50° field of view · color fundus photograph — 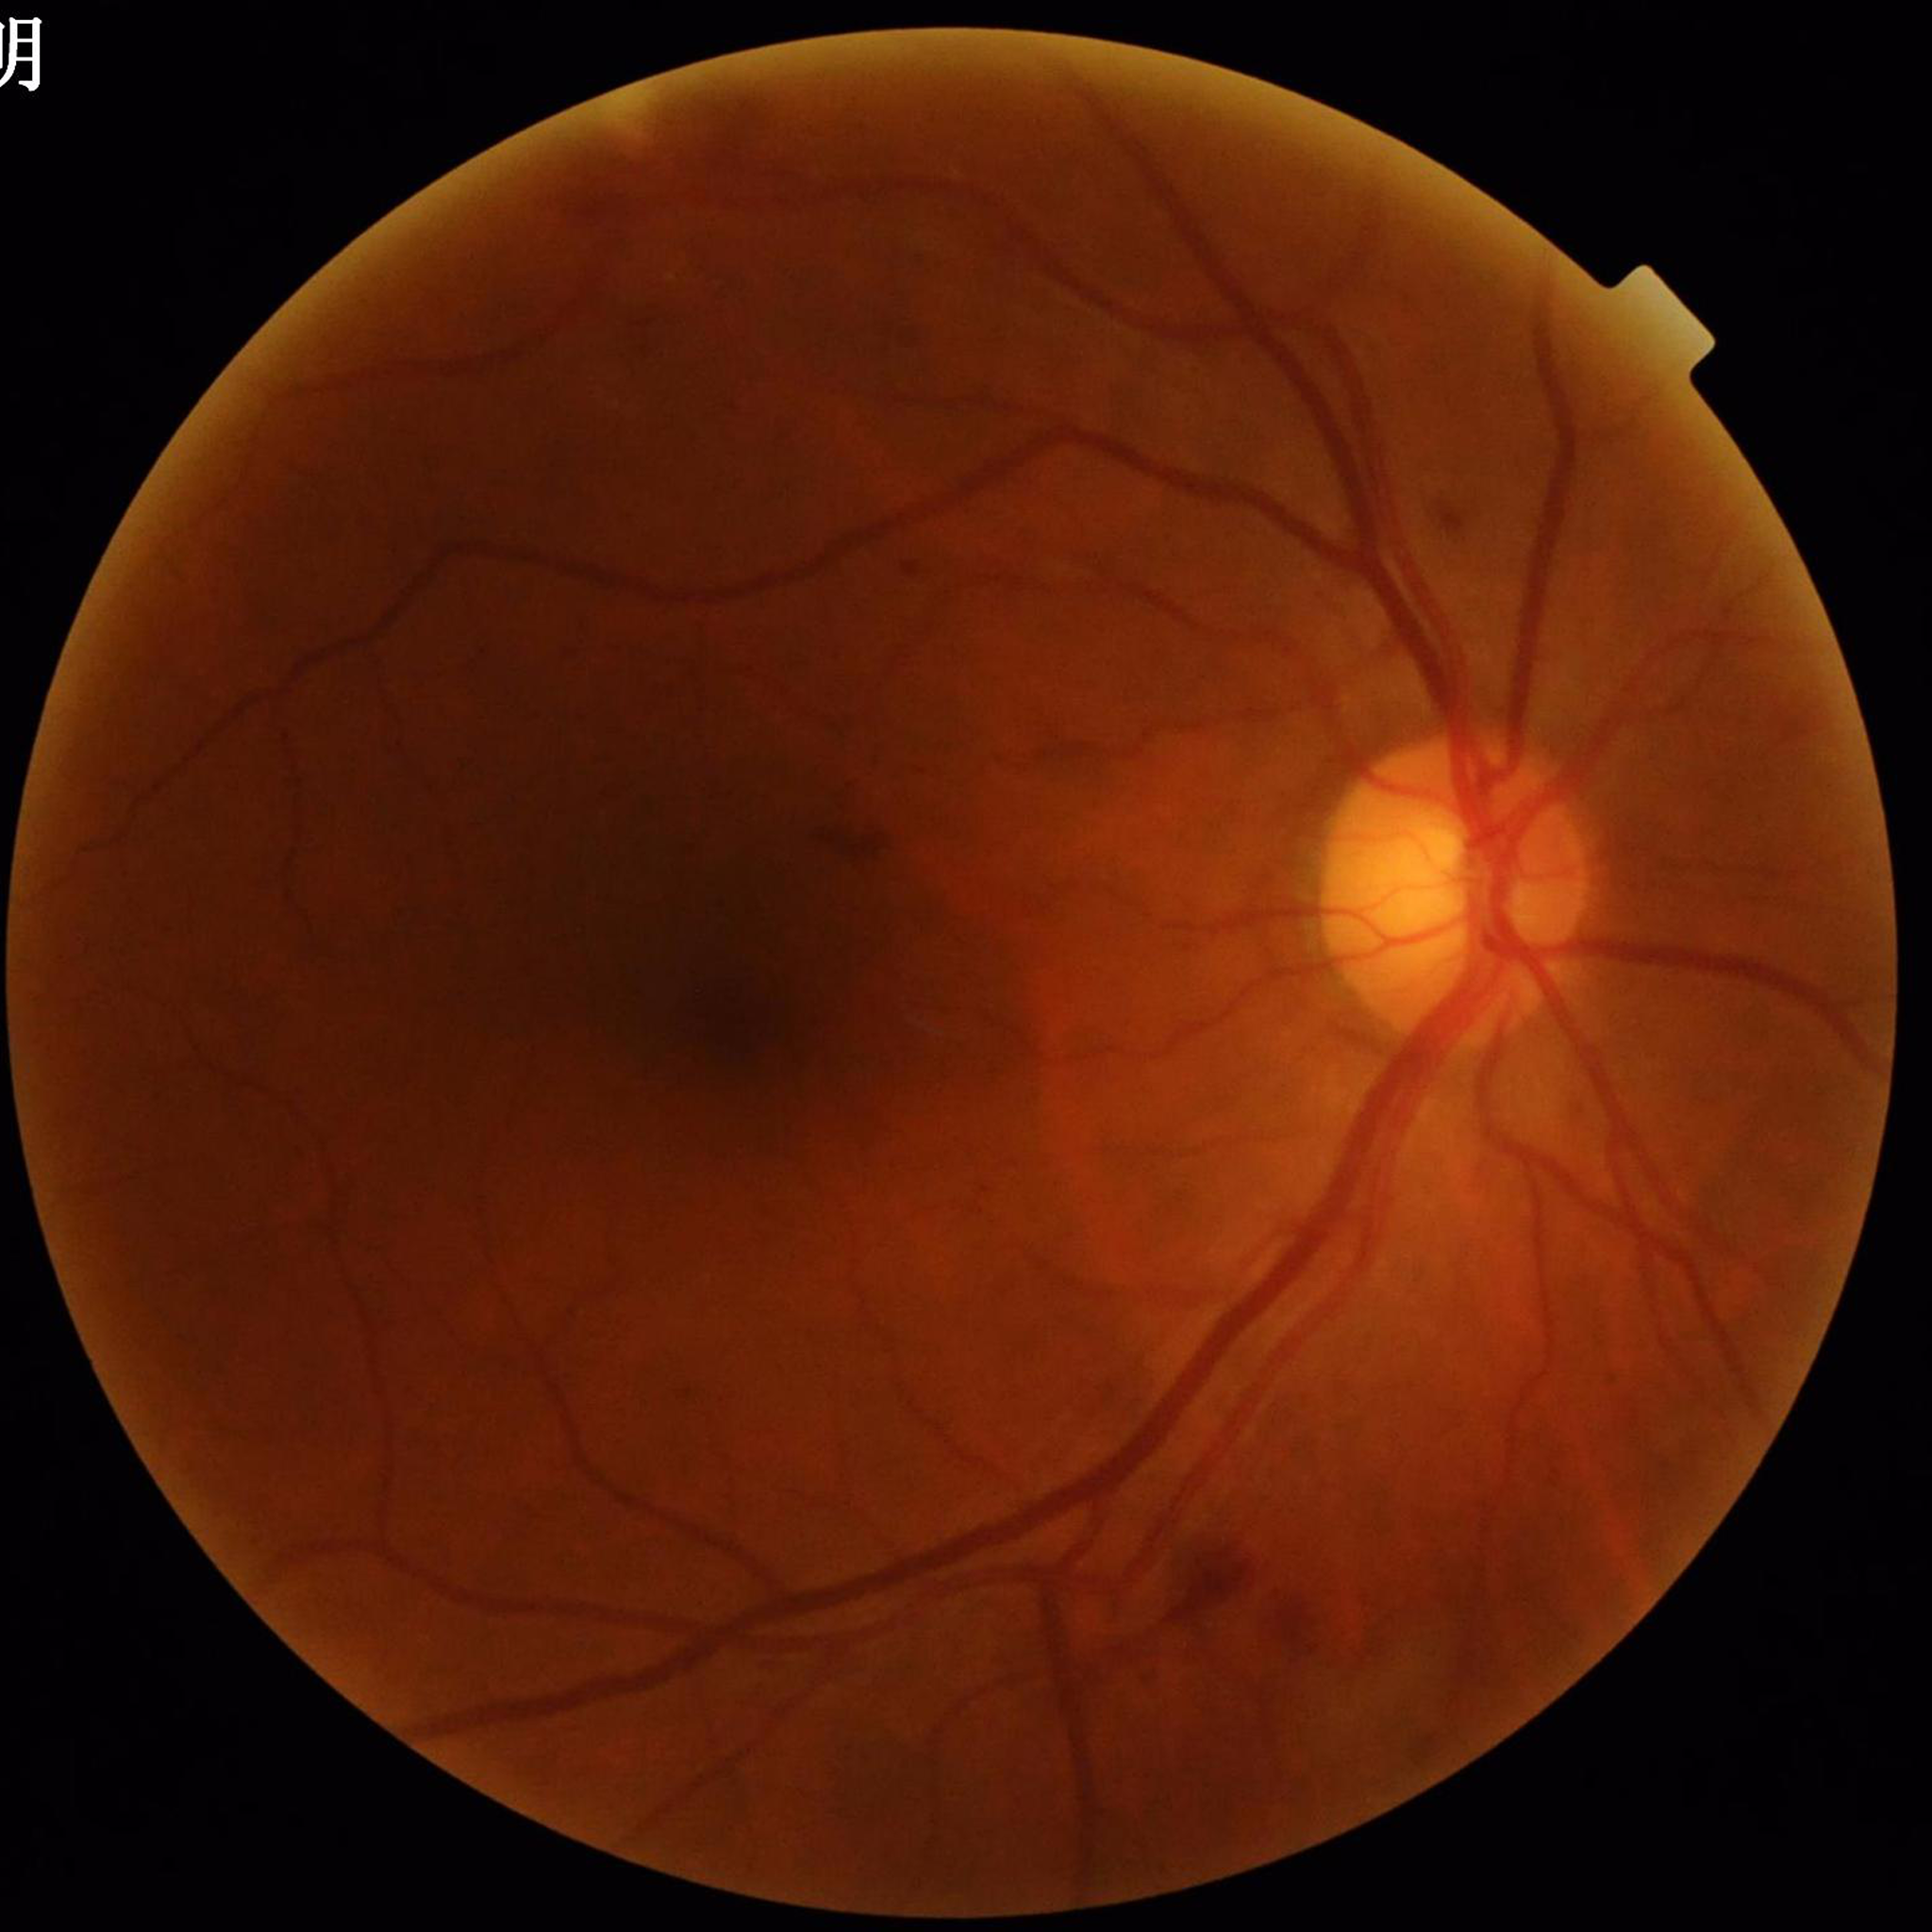 diagnosis: DR
image_quality: good